Without pupil dilation · camera: NIDEK AFC-230 · 45-degree field of view:
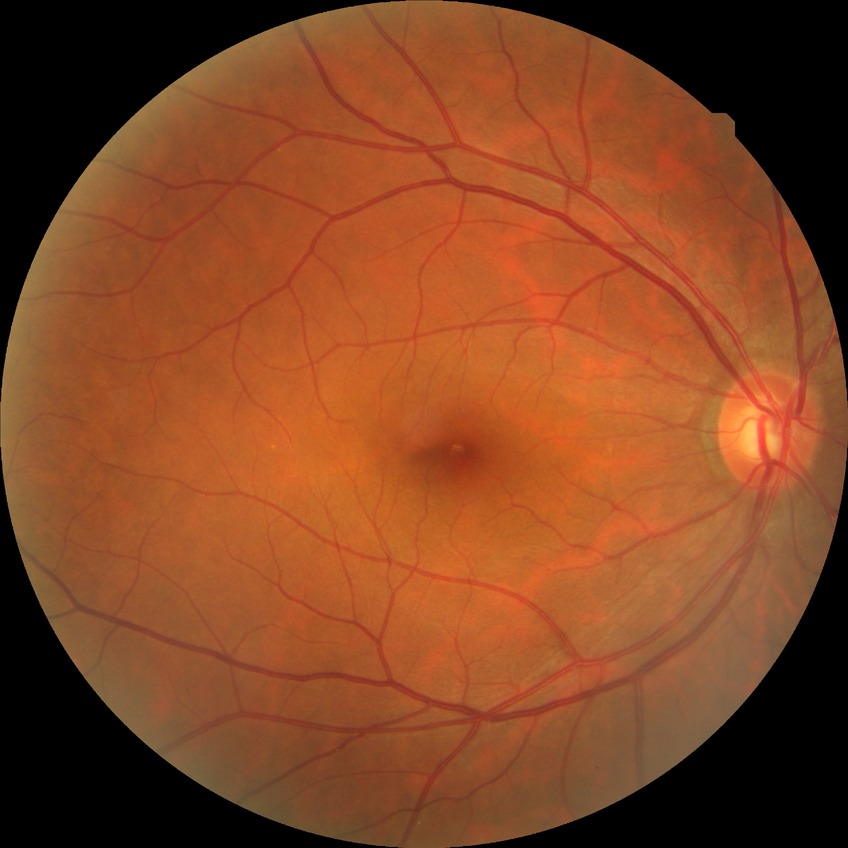 Assessment:
• diabetic retinopathy (DR): NDR (no diabetic retinopathy)